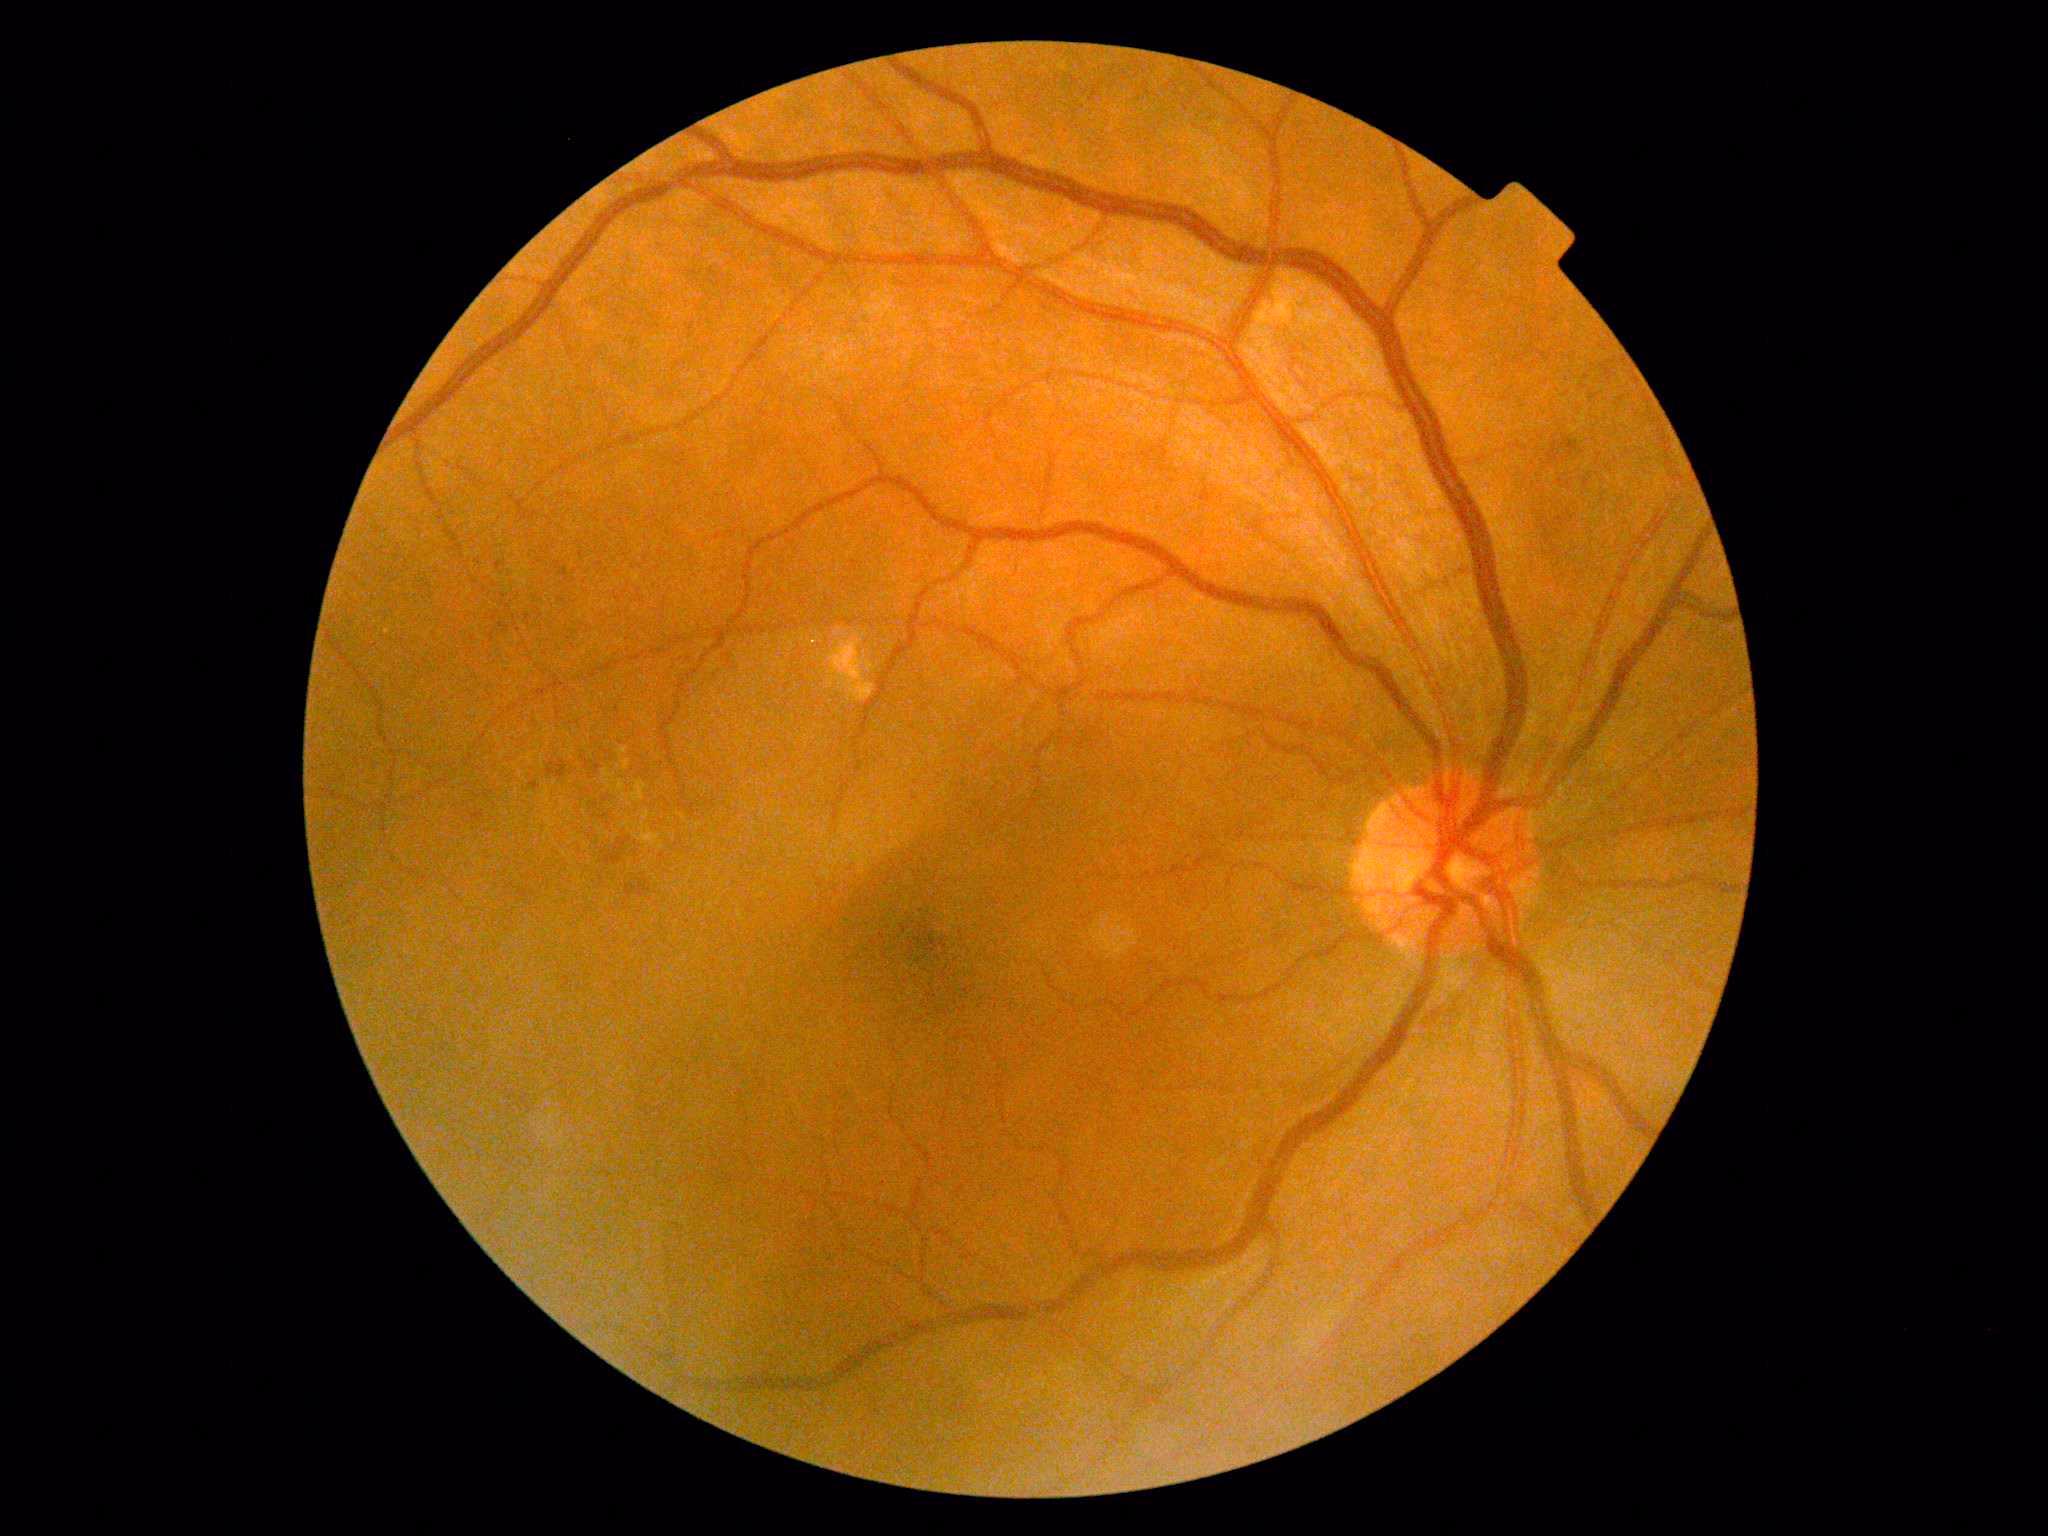
DR grade: 2 (moderate NPDR); DR class: non-proliferative diabetic retinopathy.